CFP; 2352x1568:
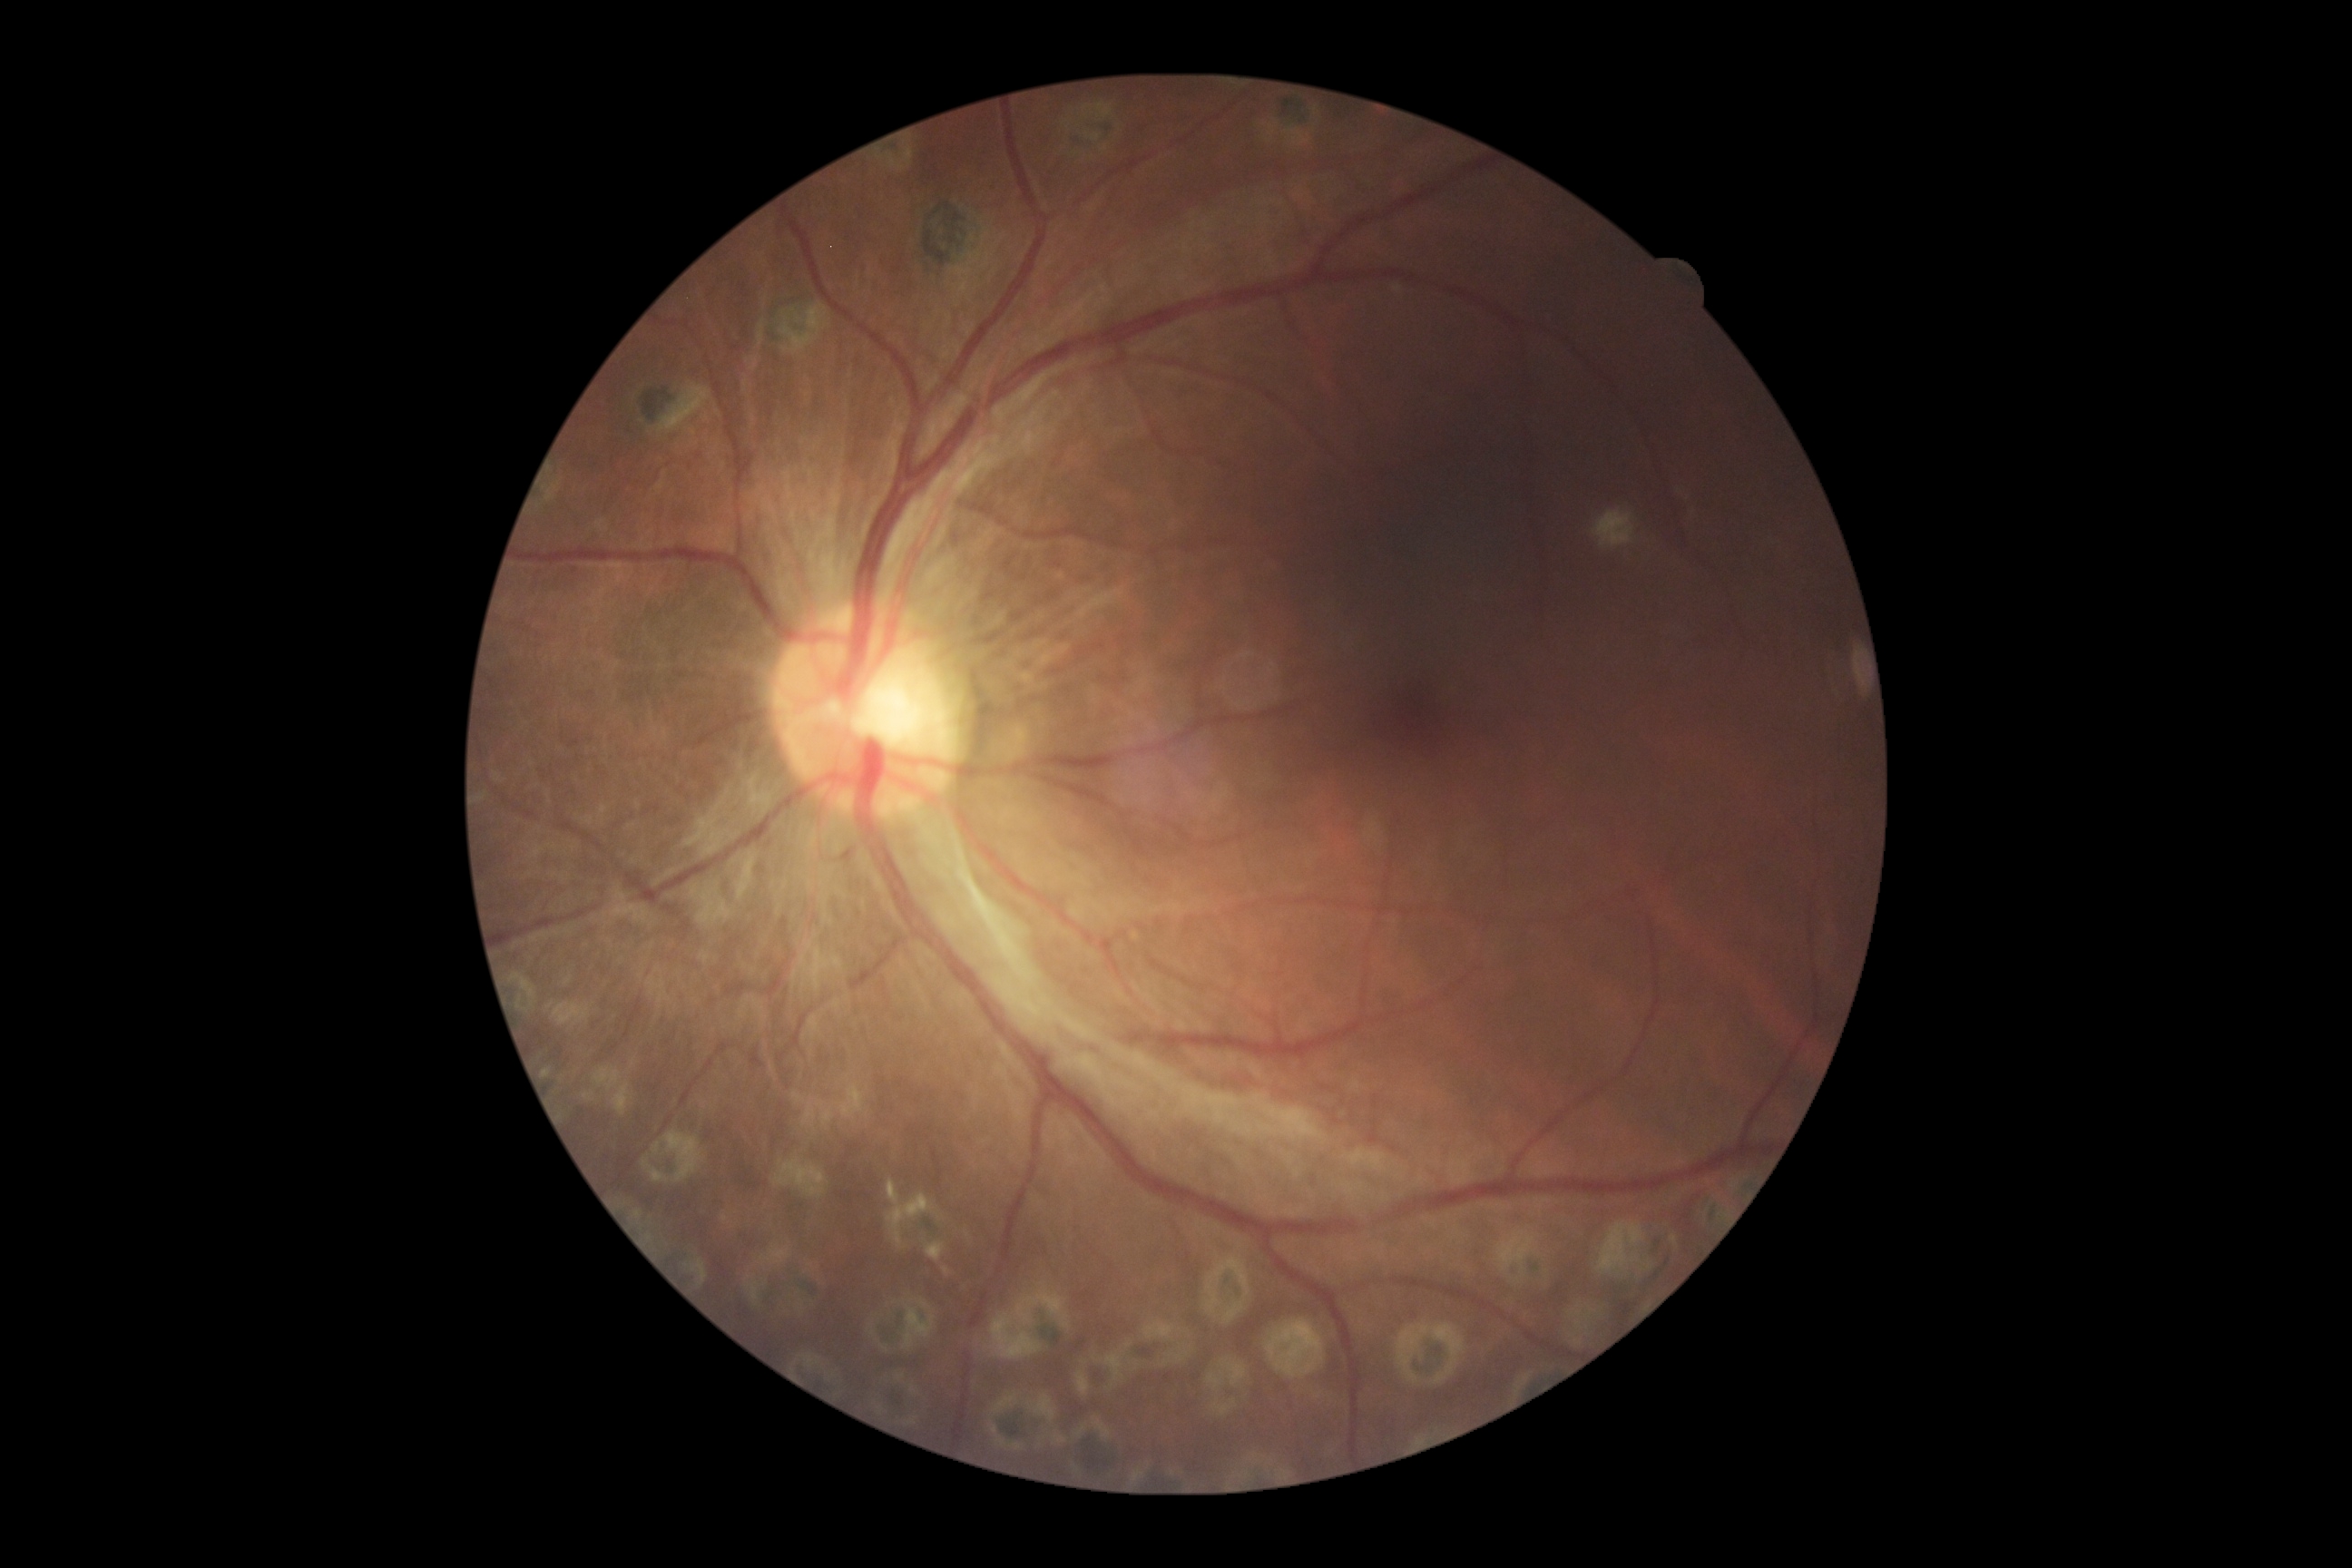 – DR stage: 4
– DR class: proliferative diabetic retinopathy